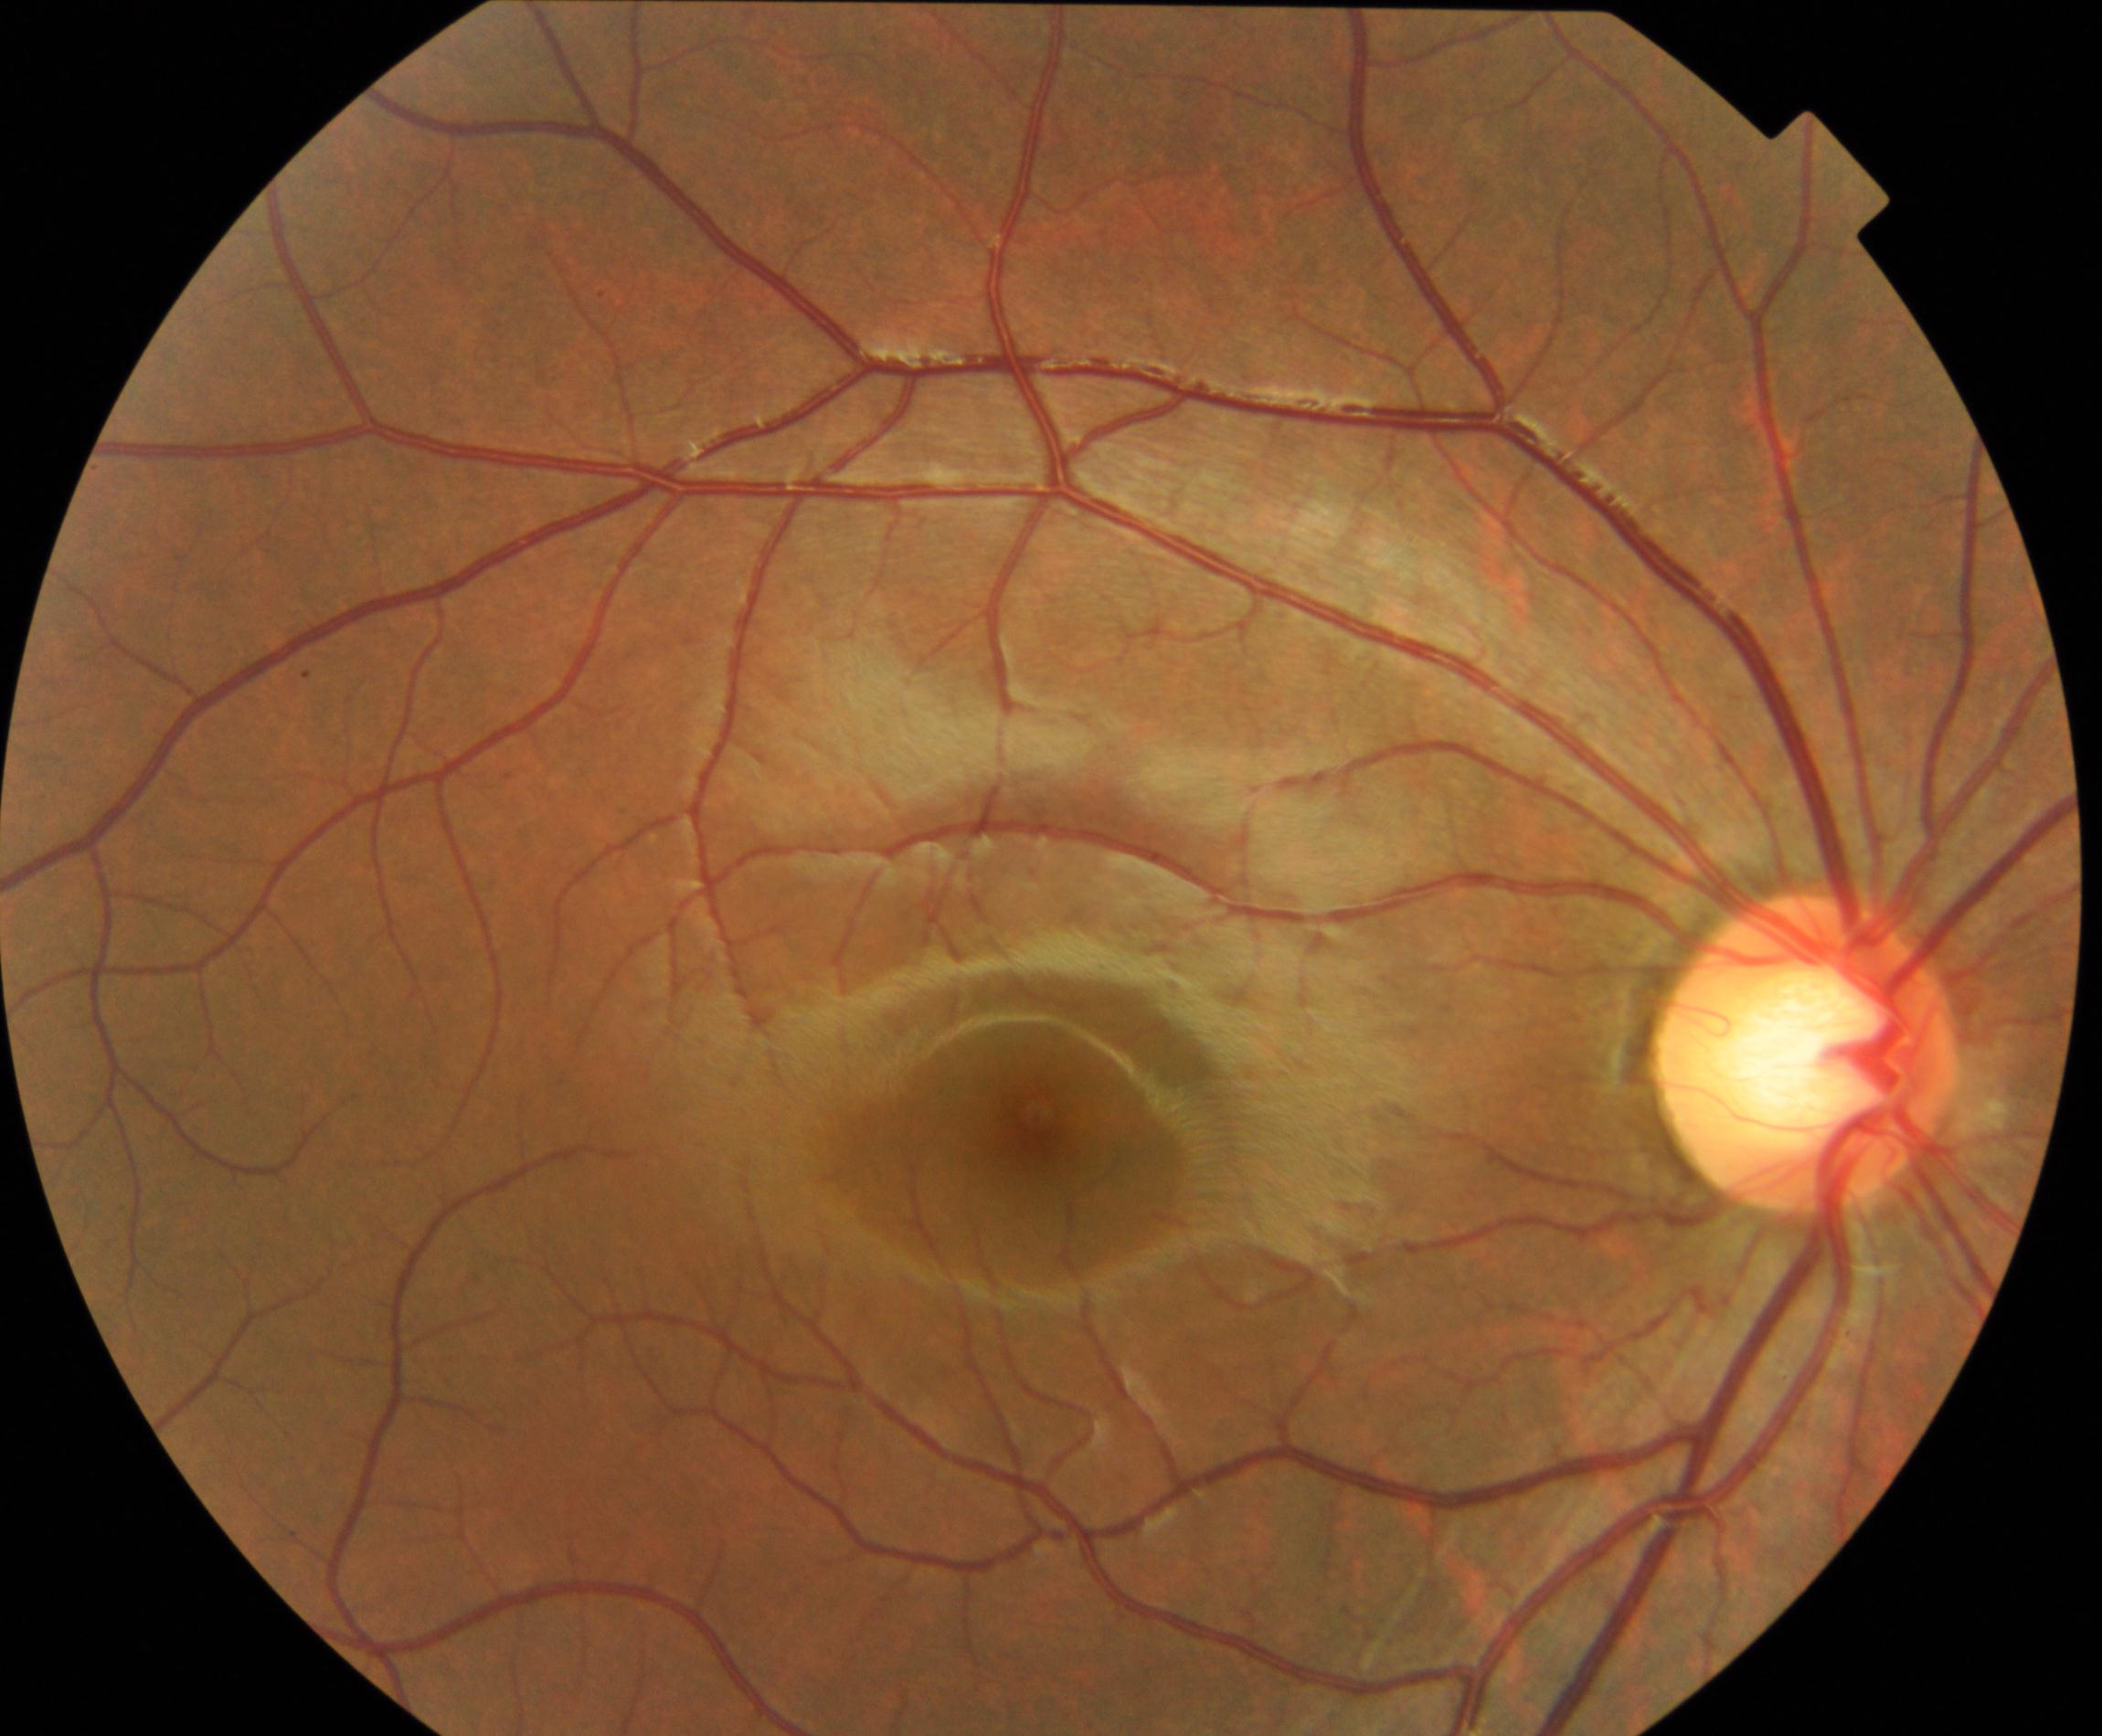

Impression: large optic cup. Defined by cup-to-disc ratio greater than 0.5, with a pink neuroretinal rim following the ISNT rule, without notching or bayoneting of vessels.